Image size 2102x1736
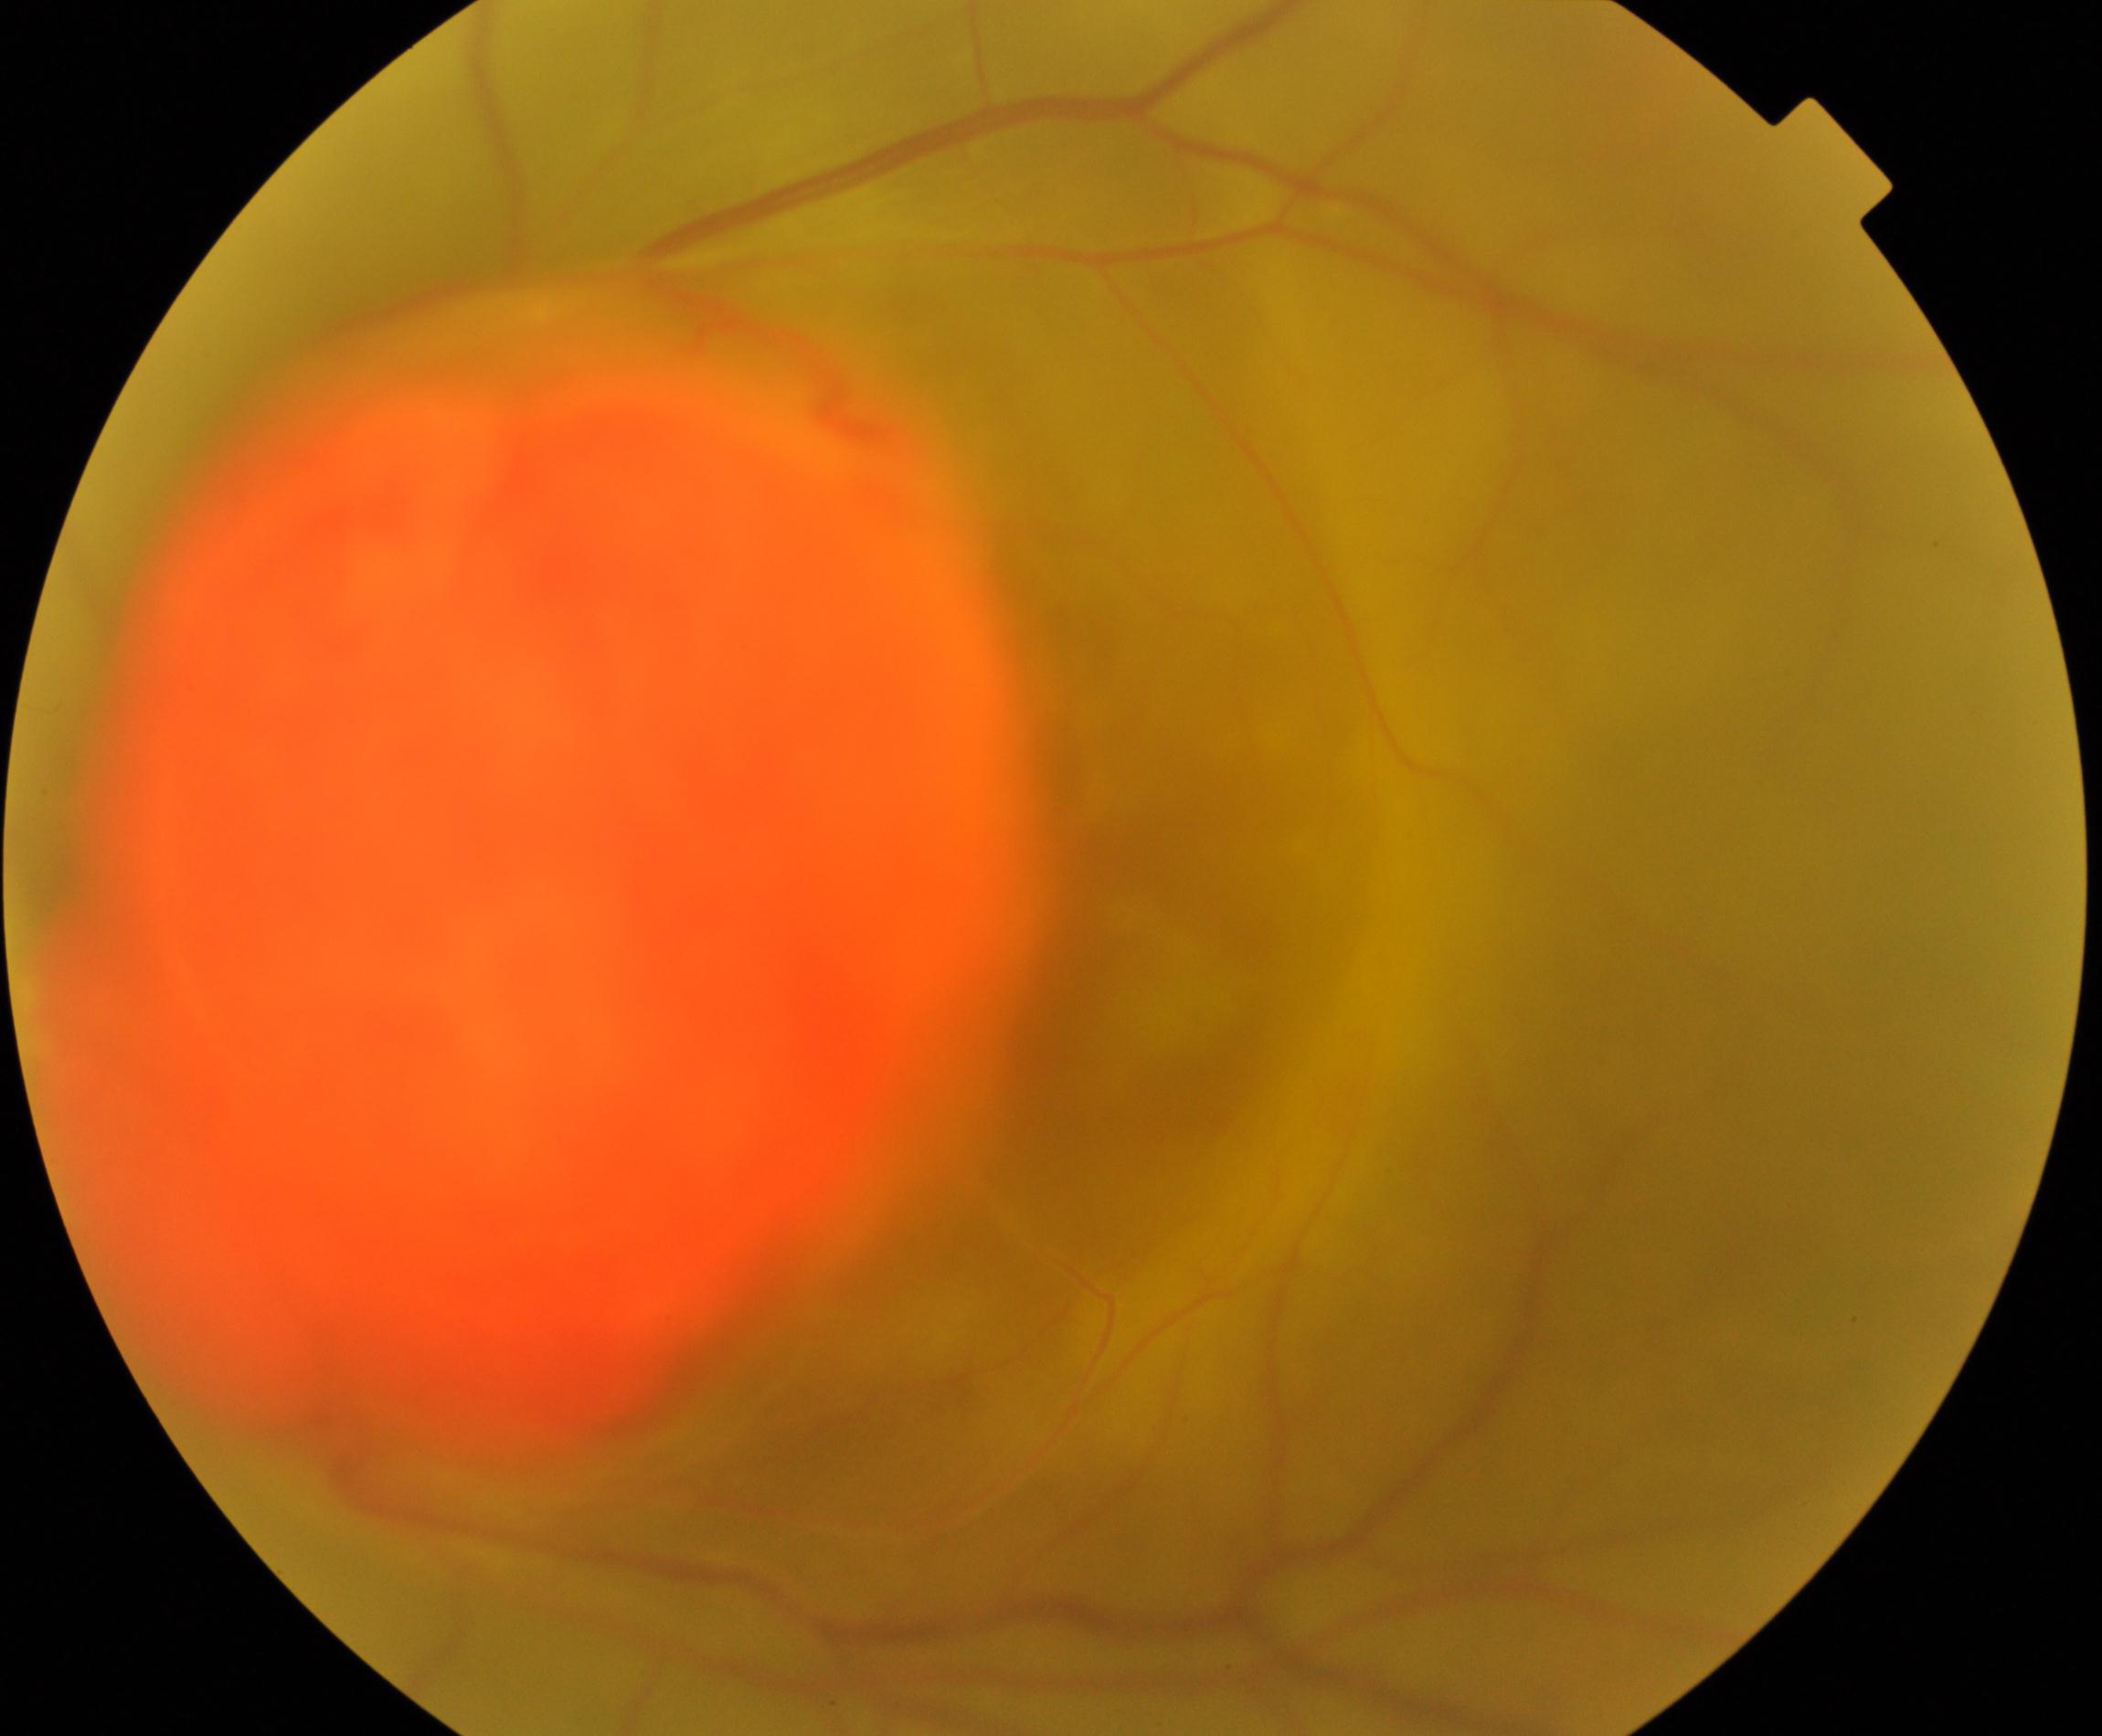
Retinal fundus photograph demonstrating fundus neoplasm.